1440 by 1080 pixels. Wide-field fundus image from infant ROP screening.
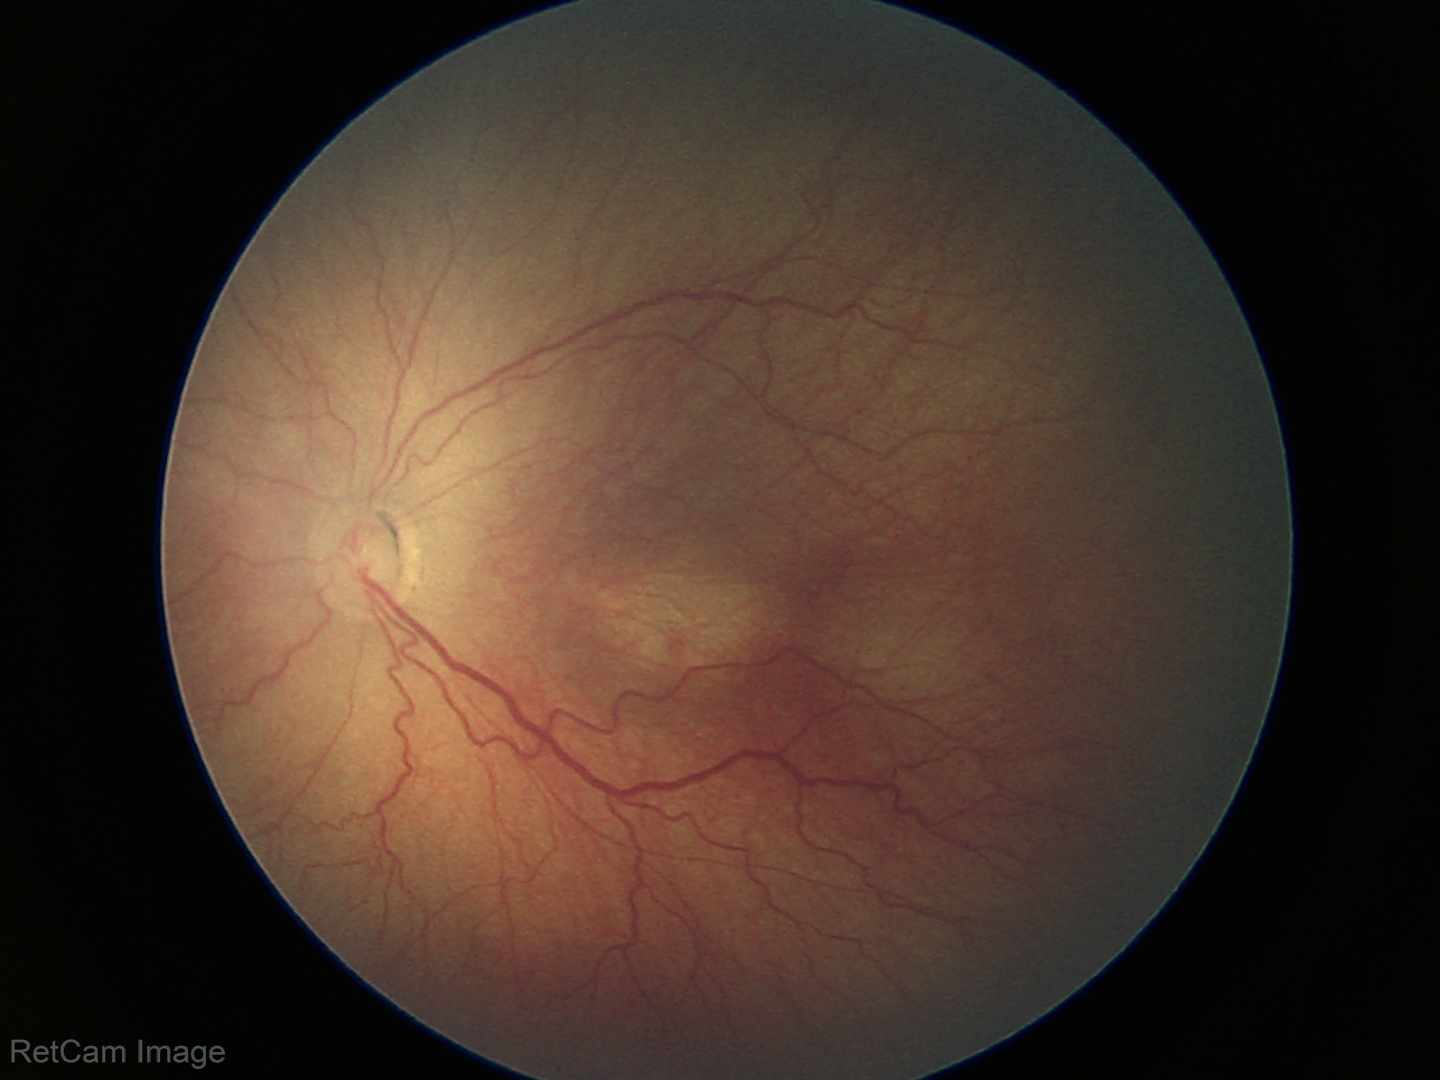

No plus disease. From an examination with diagnosis of ROP stage 3 — ridge with extraretinal fibrovascular proliferation.